Image size 2352x1568 · 45° field of view · CFP:
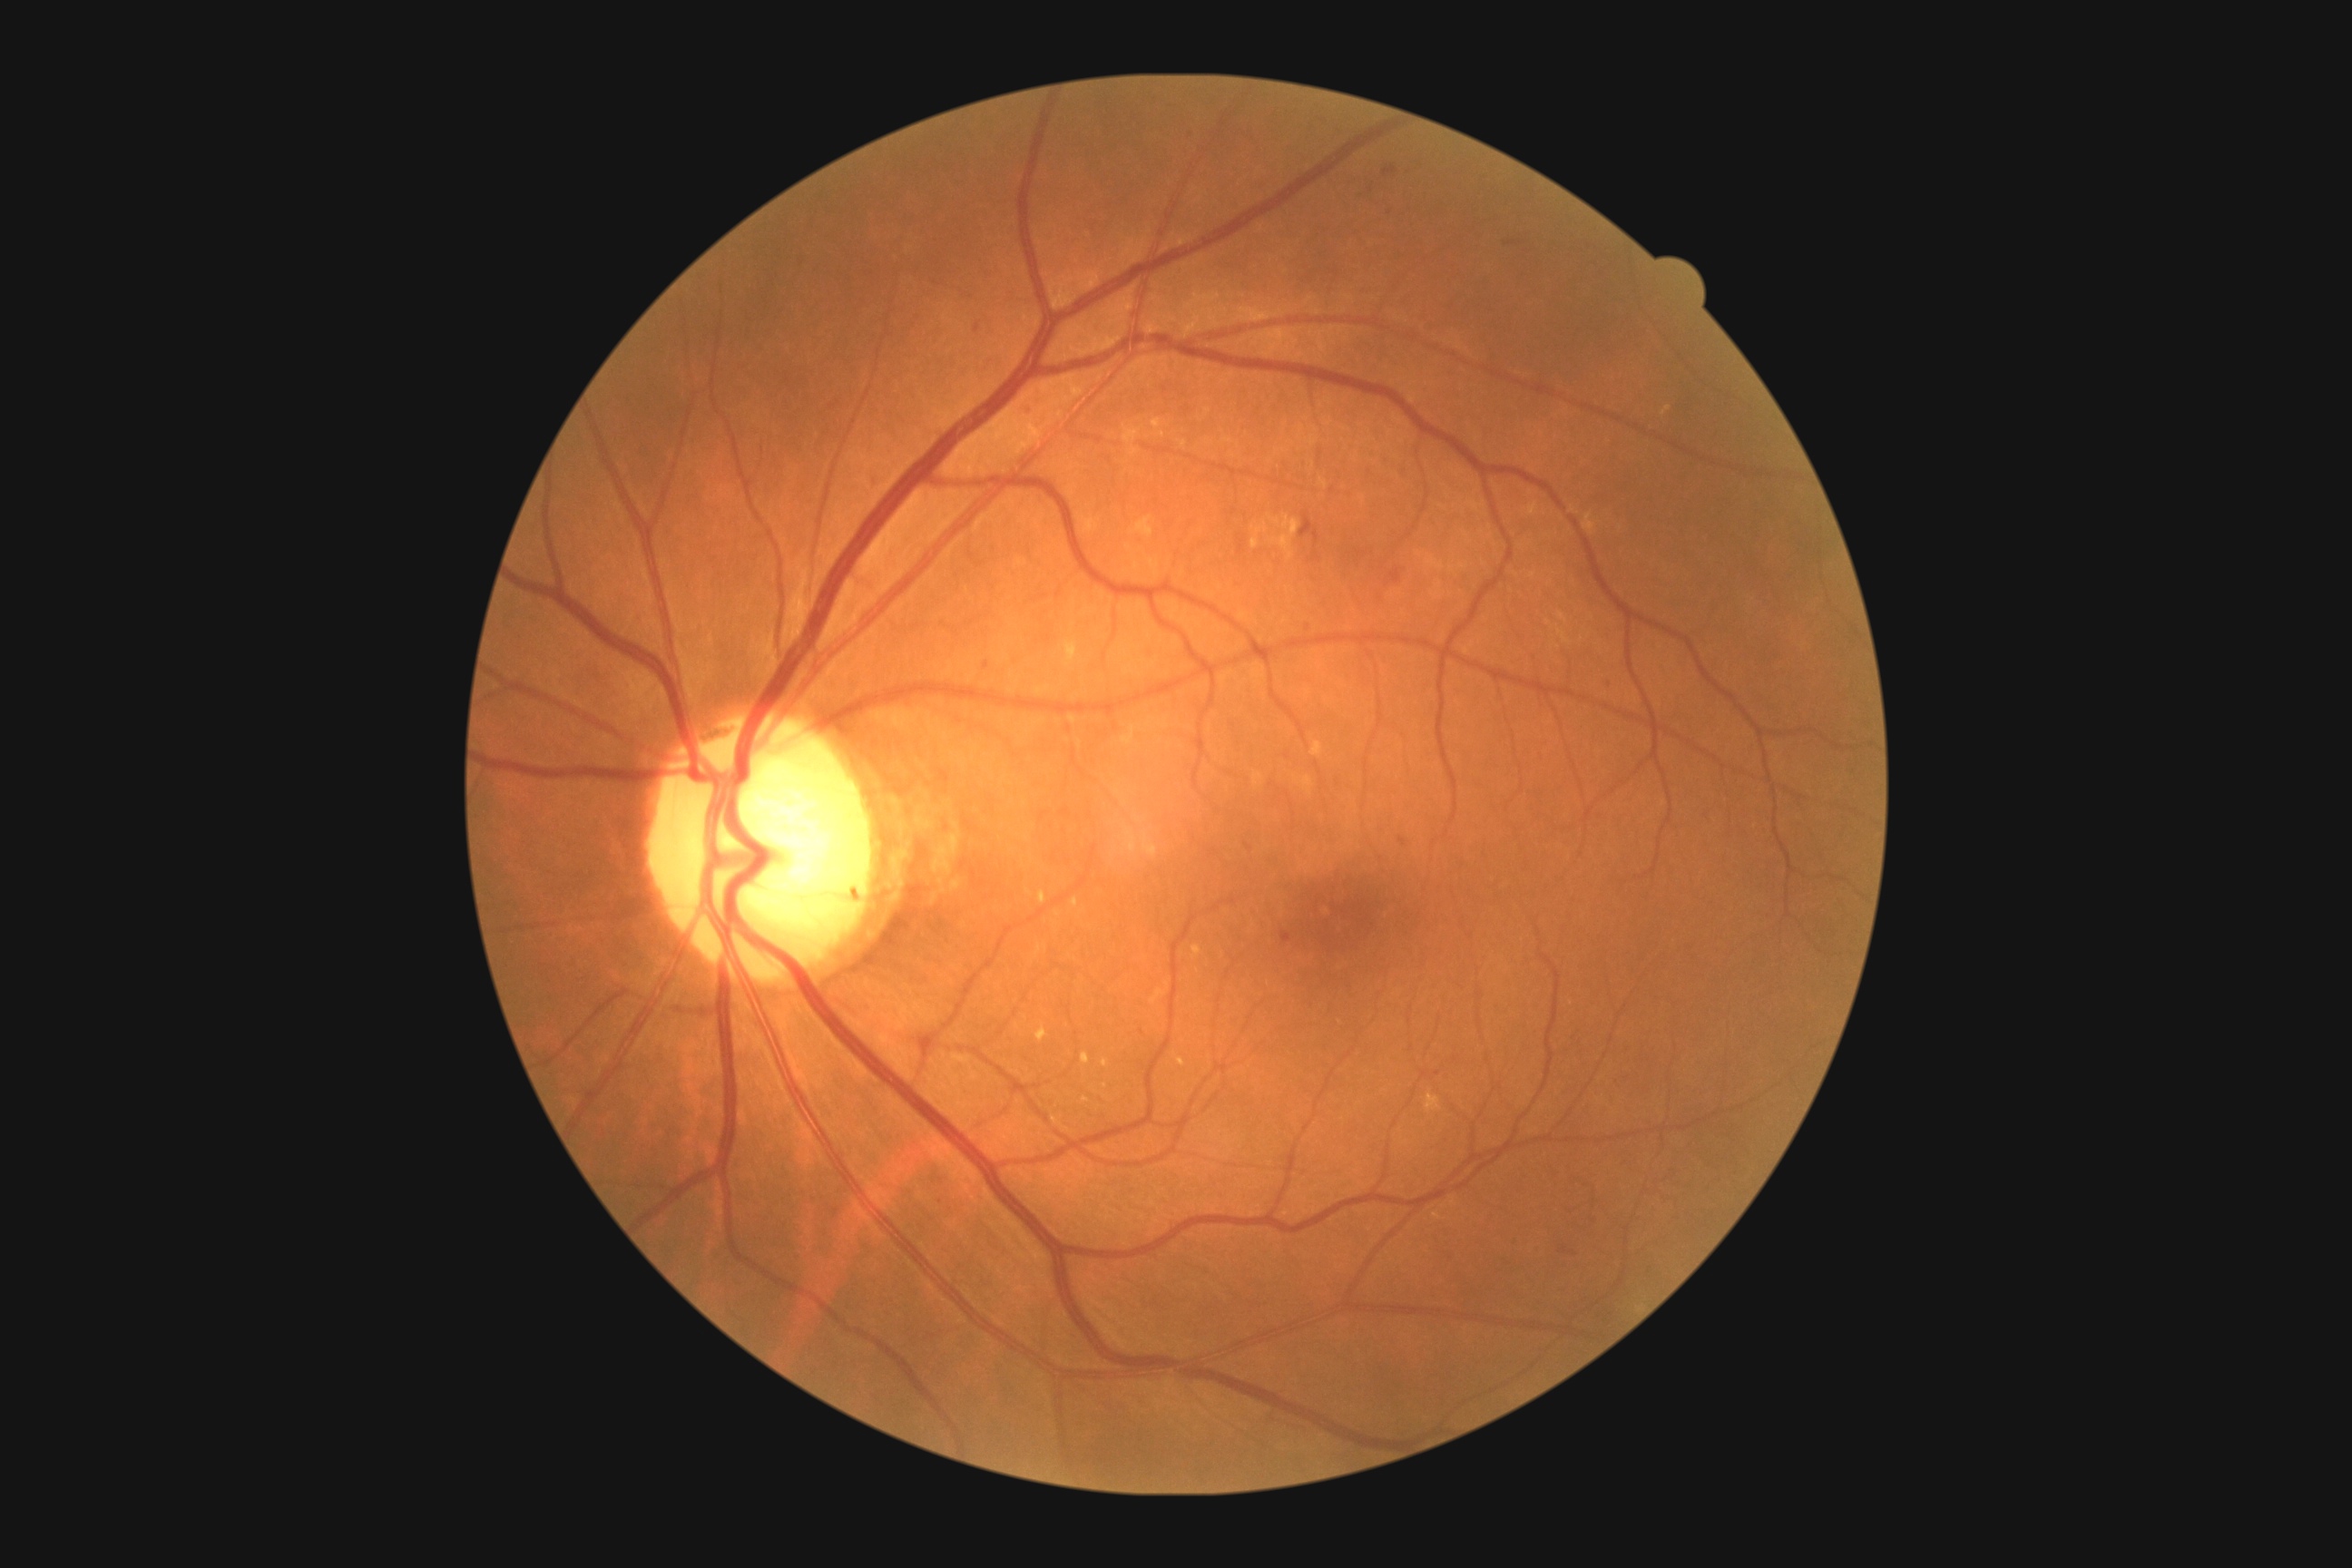 diabetic retinopathy (DR) = 2